Acquired on the Clarity RetCam 3. Infant wide-field fundus photograph: 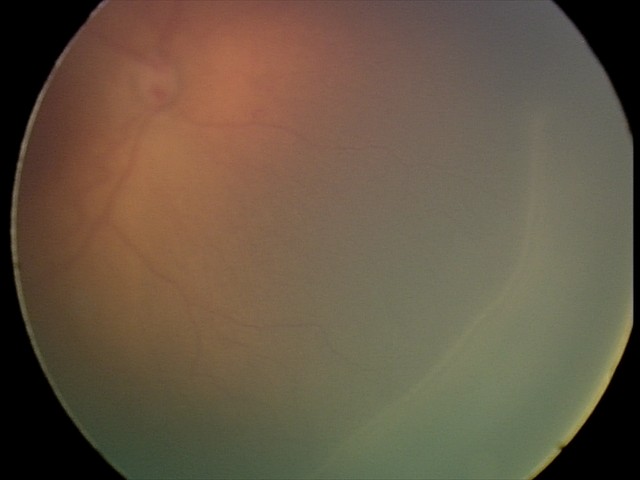 Examination diagnosed as ROP stage 2.